RetCam wide-field infant fundus image
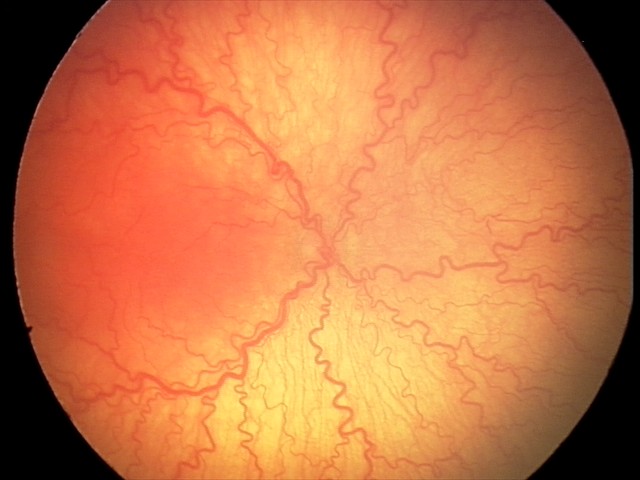 Examination diagnosed as aggressive retinopathy of prematurity (A-ROP).
Plus disease present.